100° field of view (Phoenix ICON); infant wide-field retinal image; 1240x1240px: 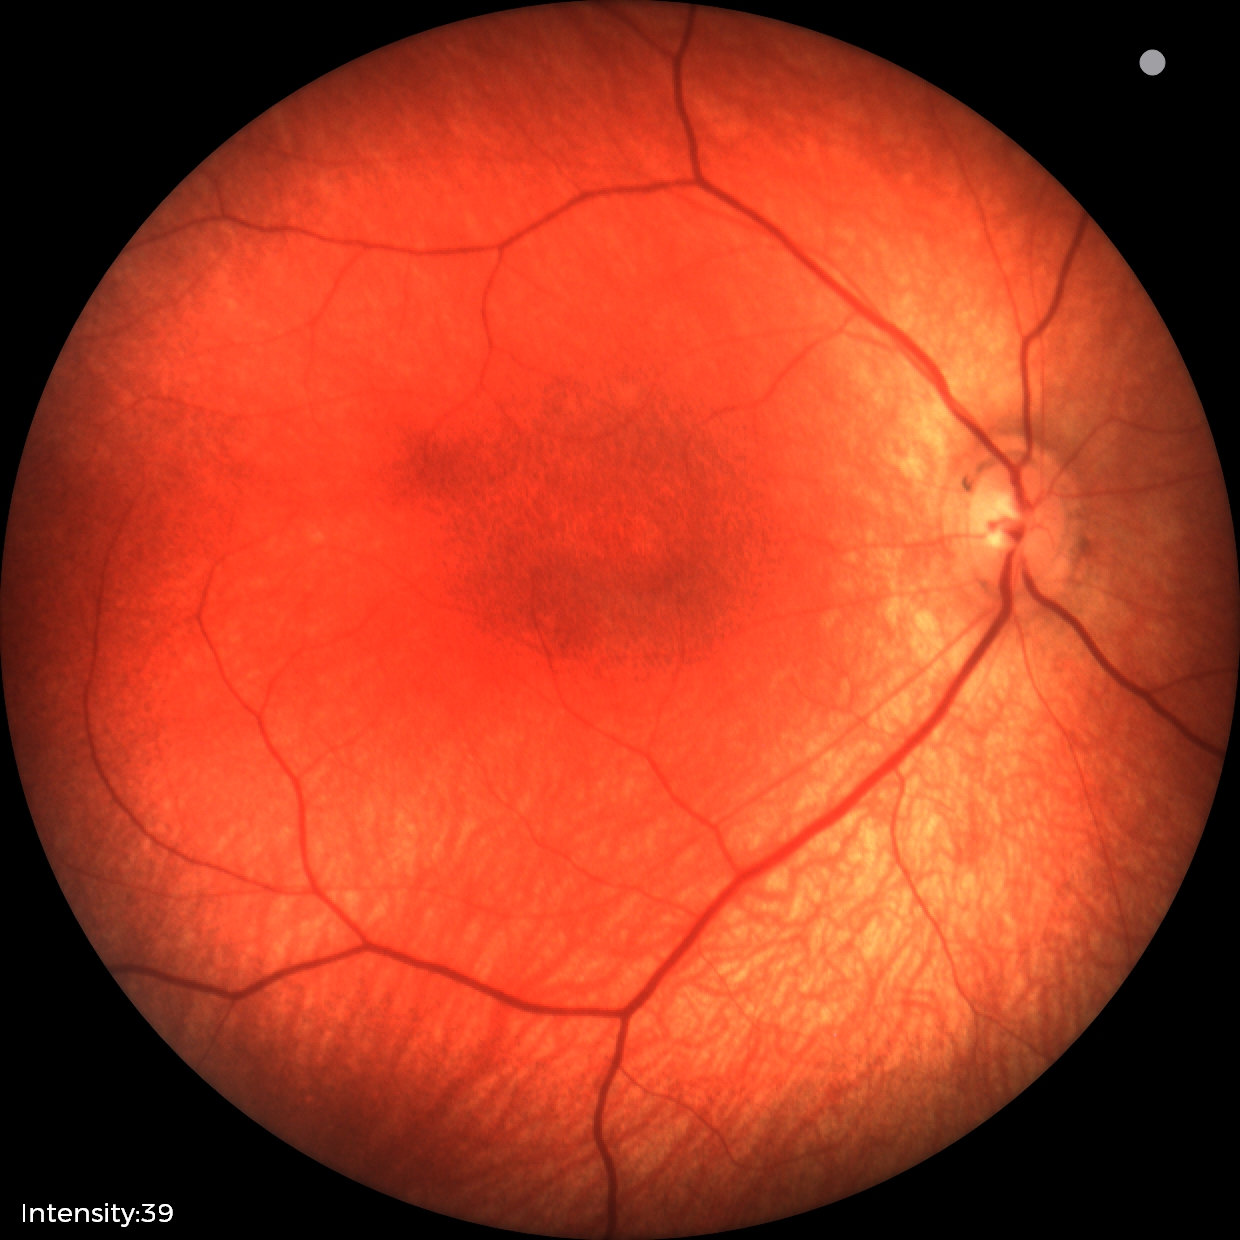

Screening examination diagnosed as physiological.